45° FOV · 2212 x 1659 pixels · color fundus image: 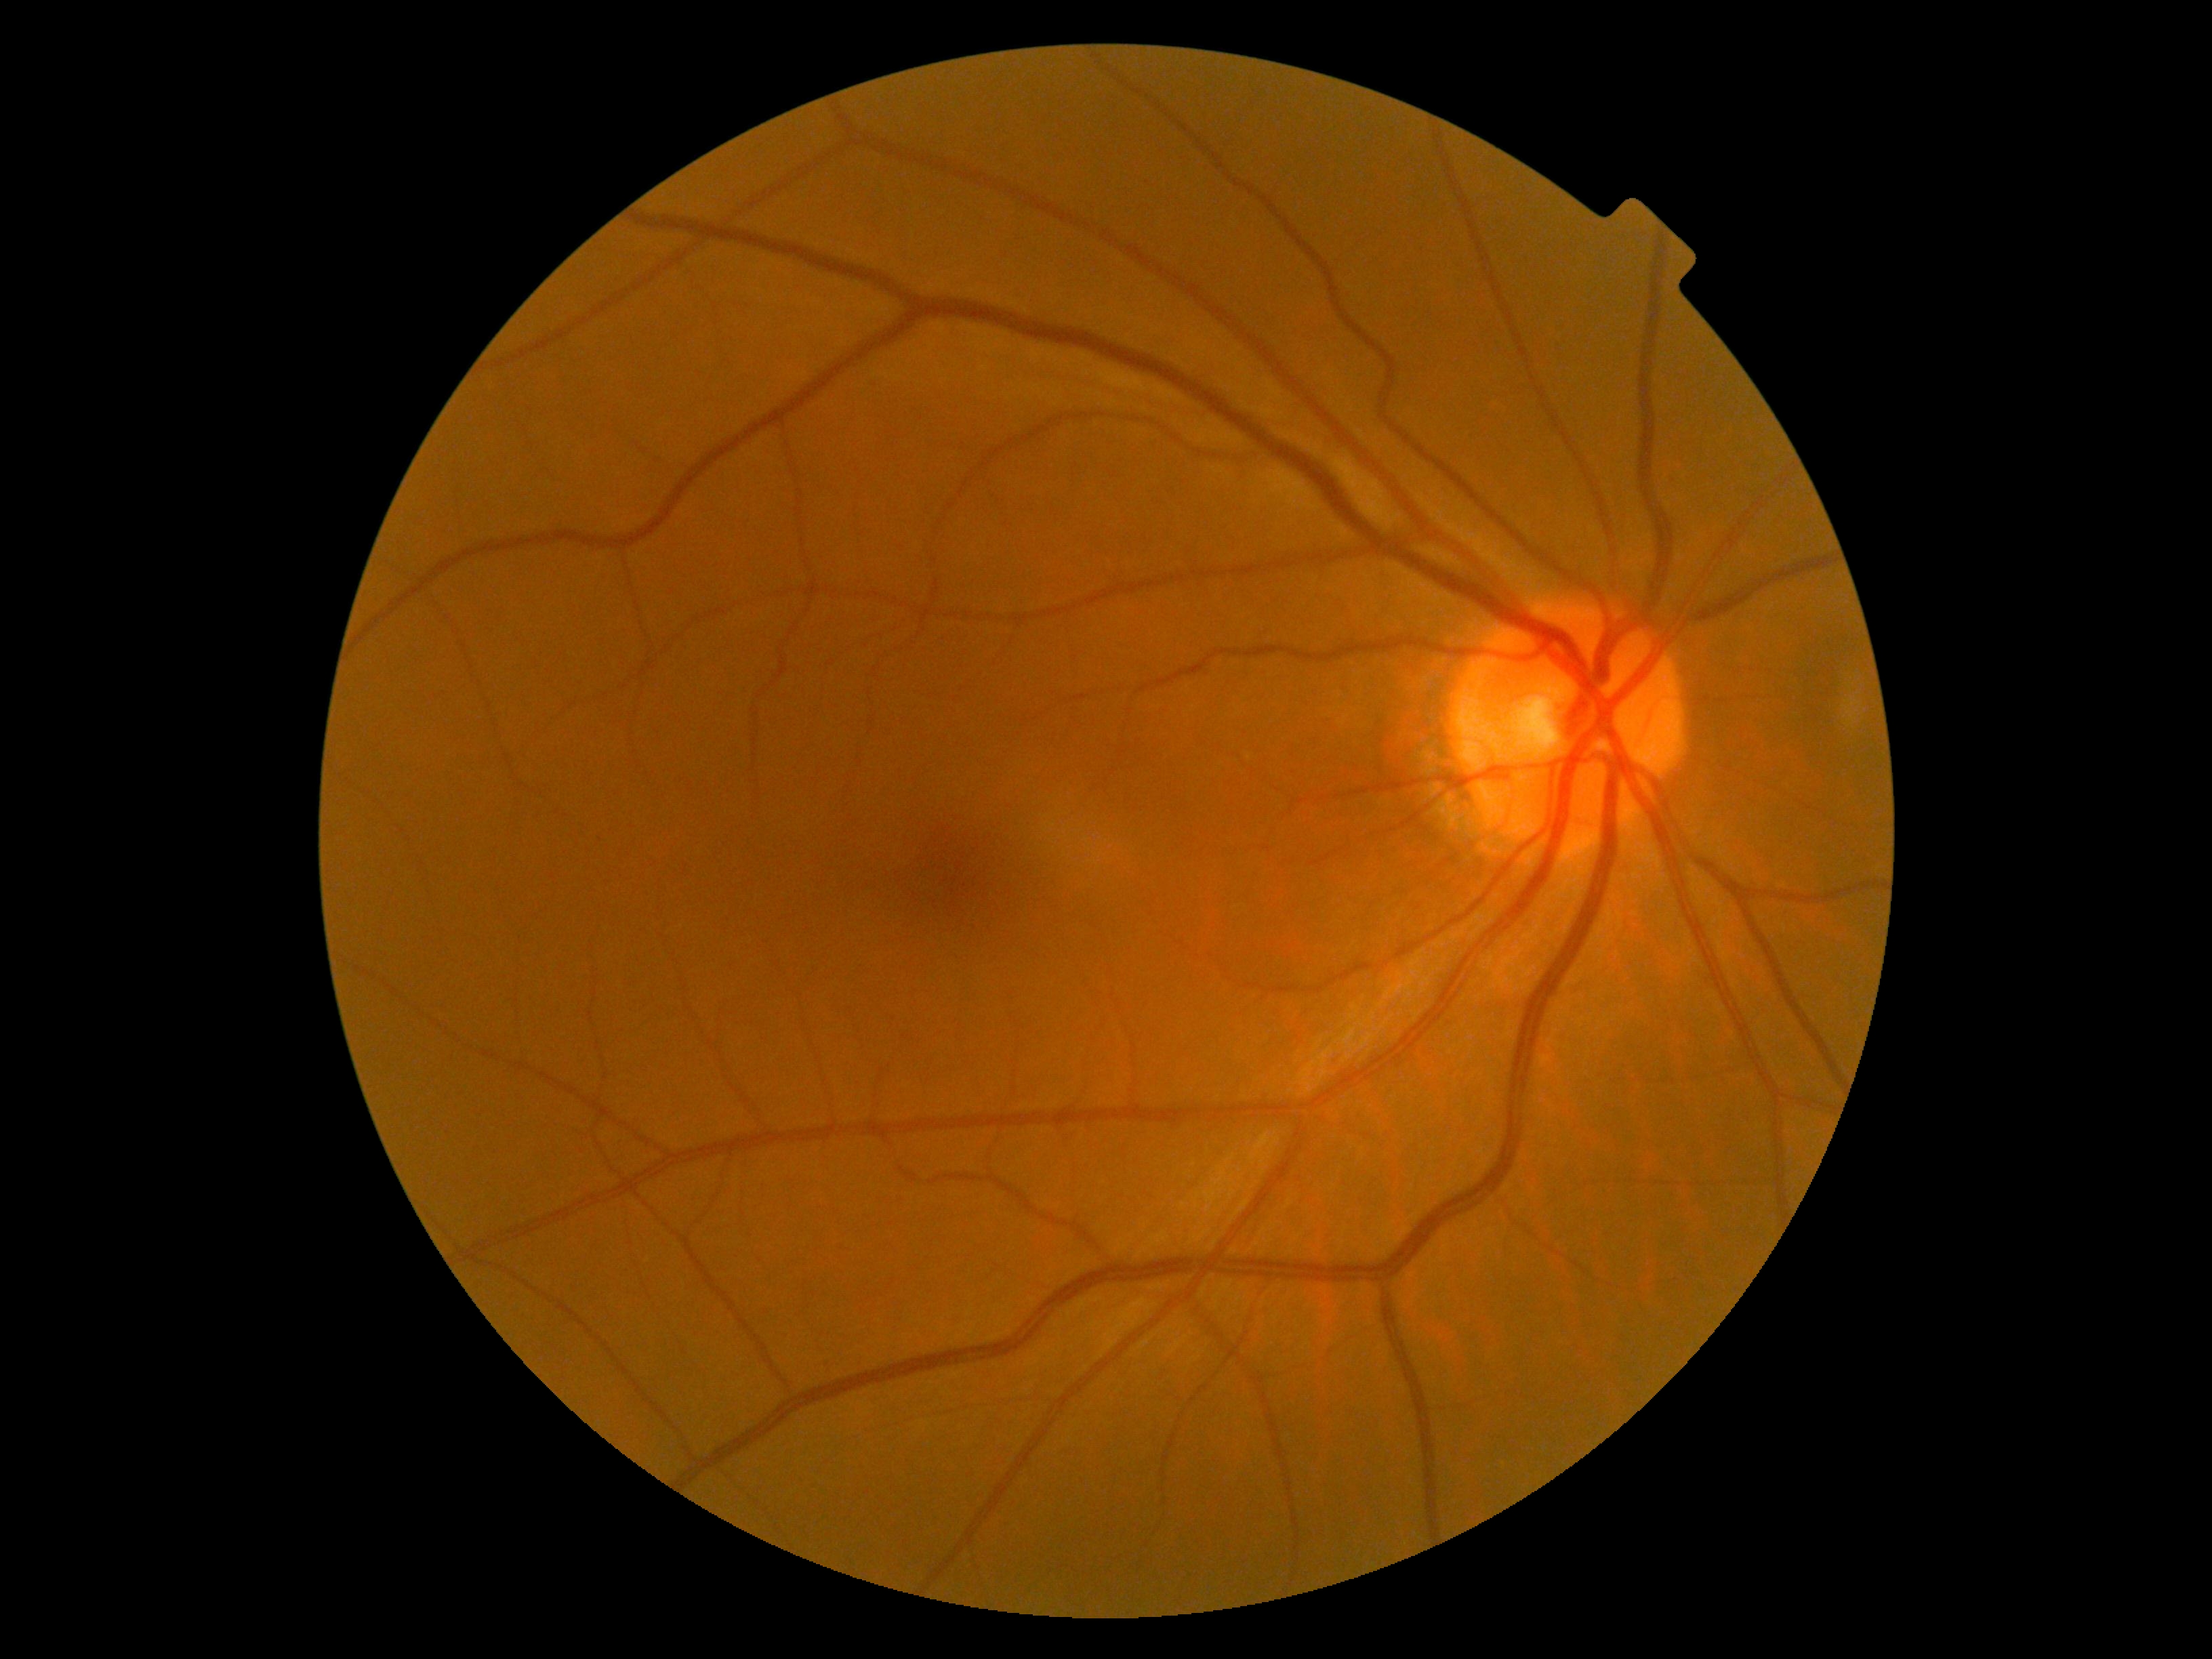
DR is grade 0 (no apparent retinopathy). No DR findings.